NIDEK AFC-230, 848 by 848 pixels, posterior pole photograph, no pharmacologic dilation, 45° field of view: 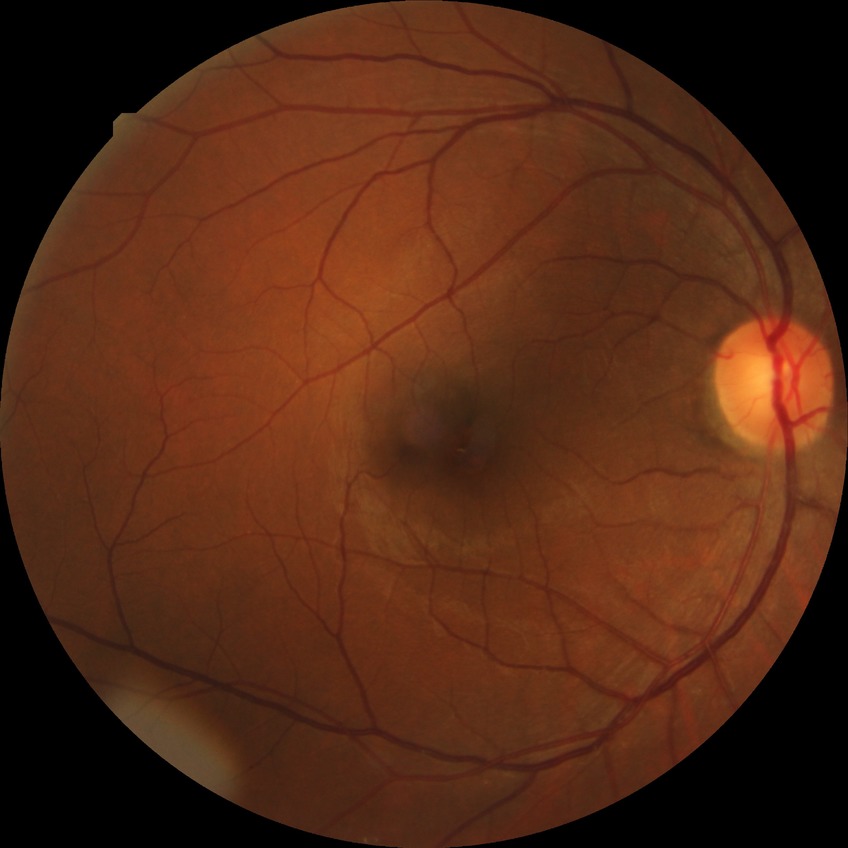

Diabetic retinopathy grade: no diabetic retinopathy.